322x322px. Color fundus photograph centered on the optic disc
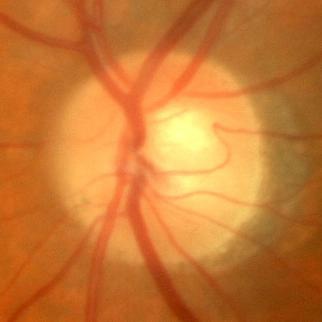 Glaucoma status = no glaucomatous damage.